45 degree fundus photograph. Color fundus photograph
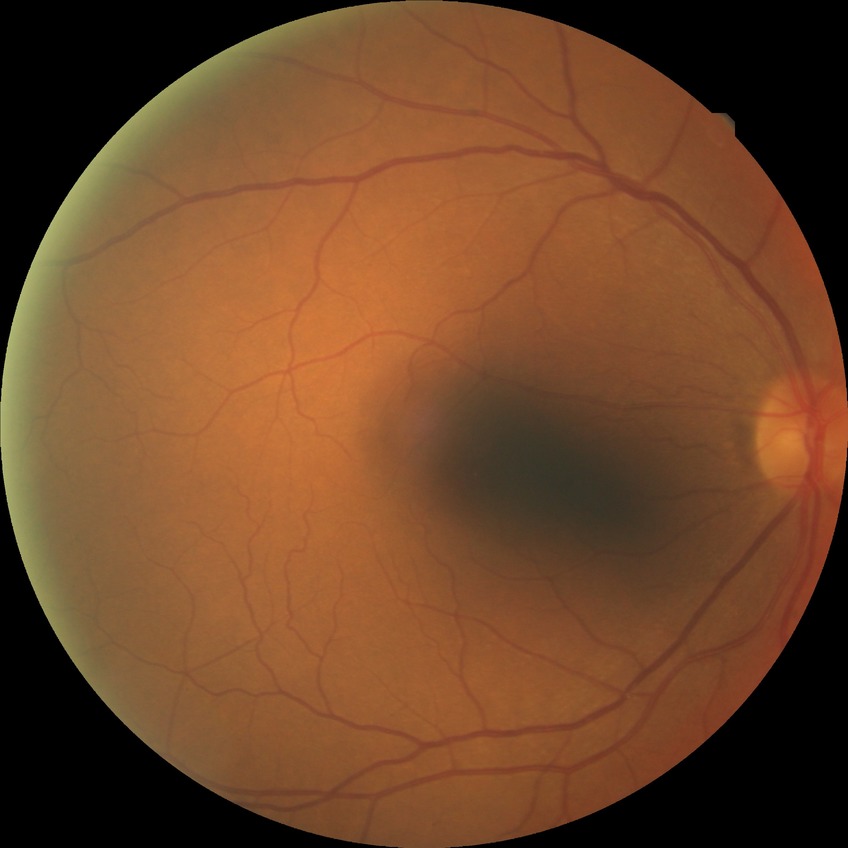
Diabetic retinopathy severity is no diabetic retinopathy.